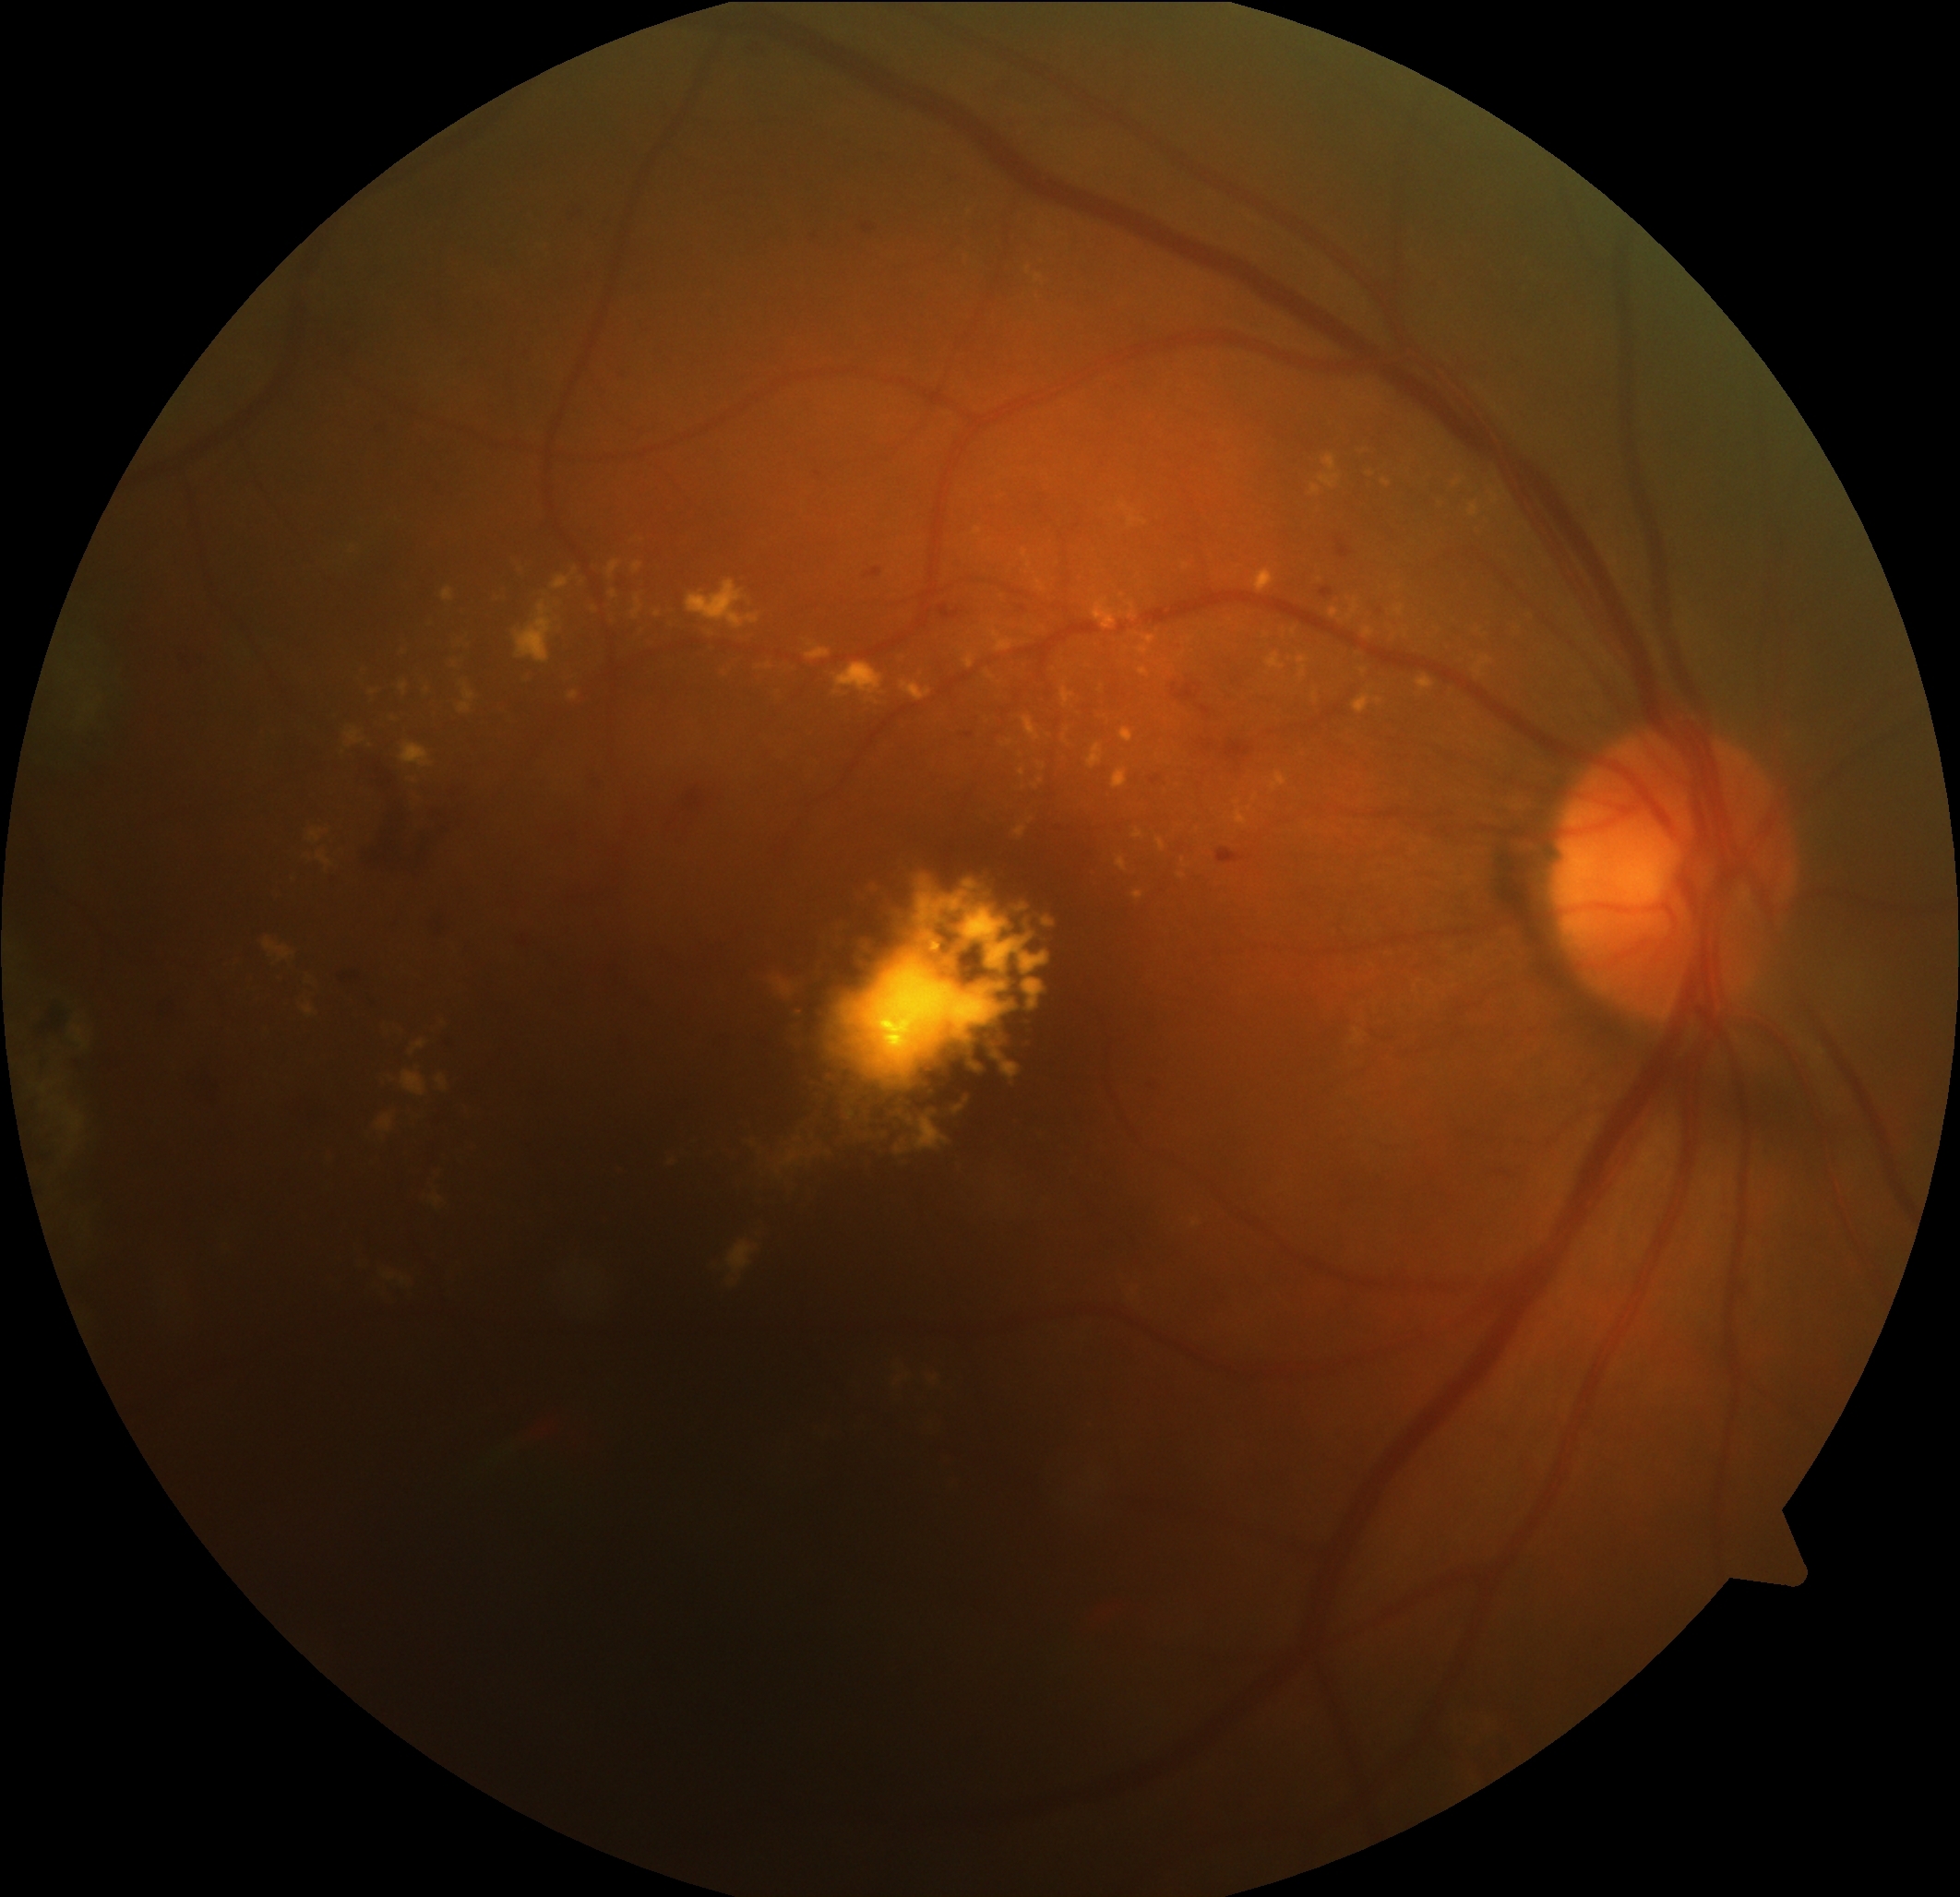

Diabetic retinopathy is grade 2.
DR class: non-proliferative diabetic retinopathy.